Wide-field fundus photograph of an infant: 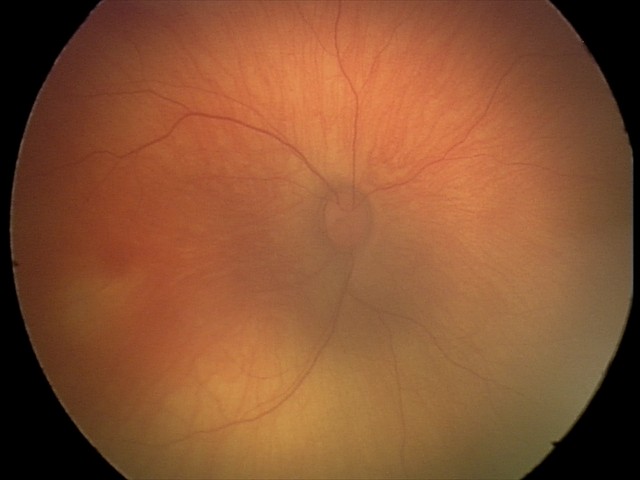 Screening examination consistent with retinal hemorrhages.